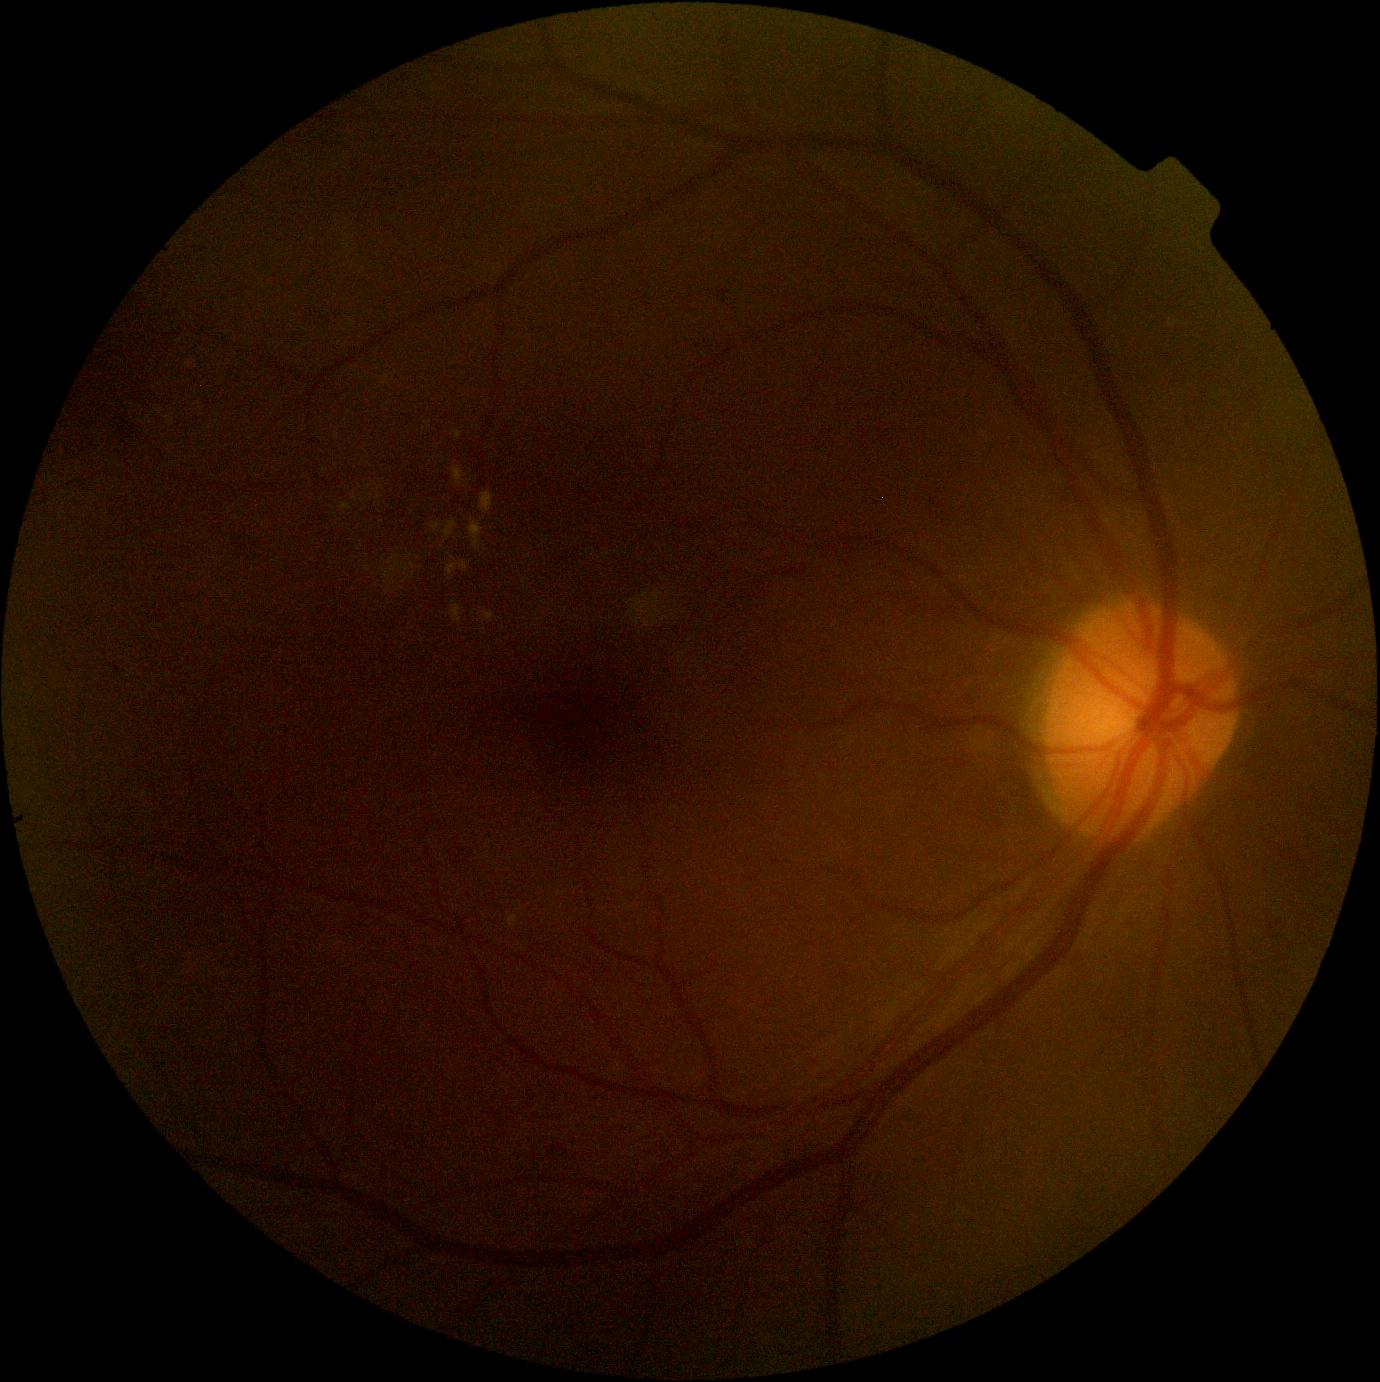

DR stage is grade 2 (moderate NPDR).
DR class: non-proliferative diabetic retinopathy.